Retinal fundus photograph.
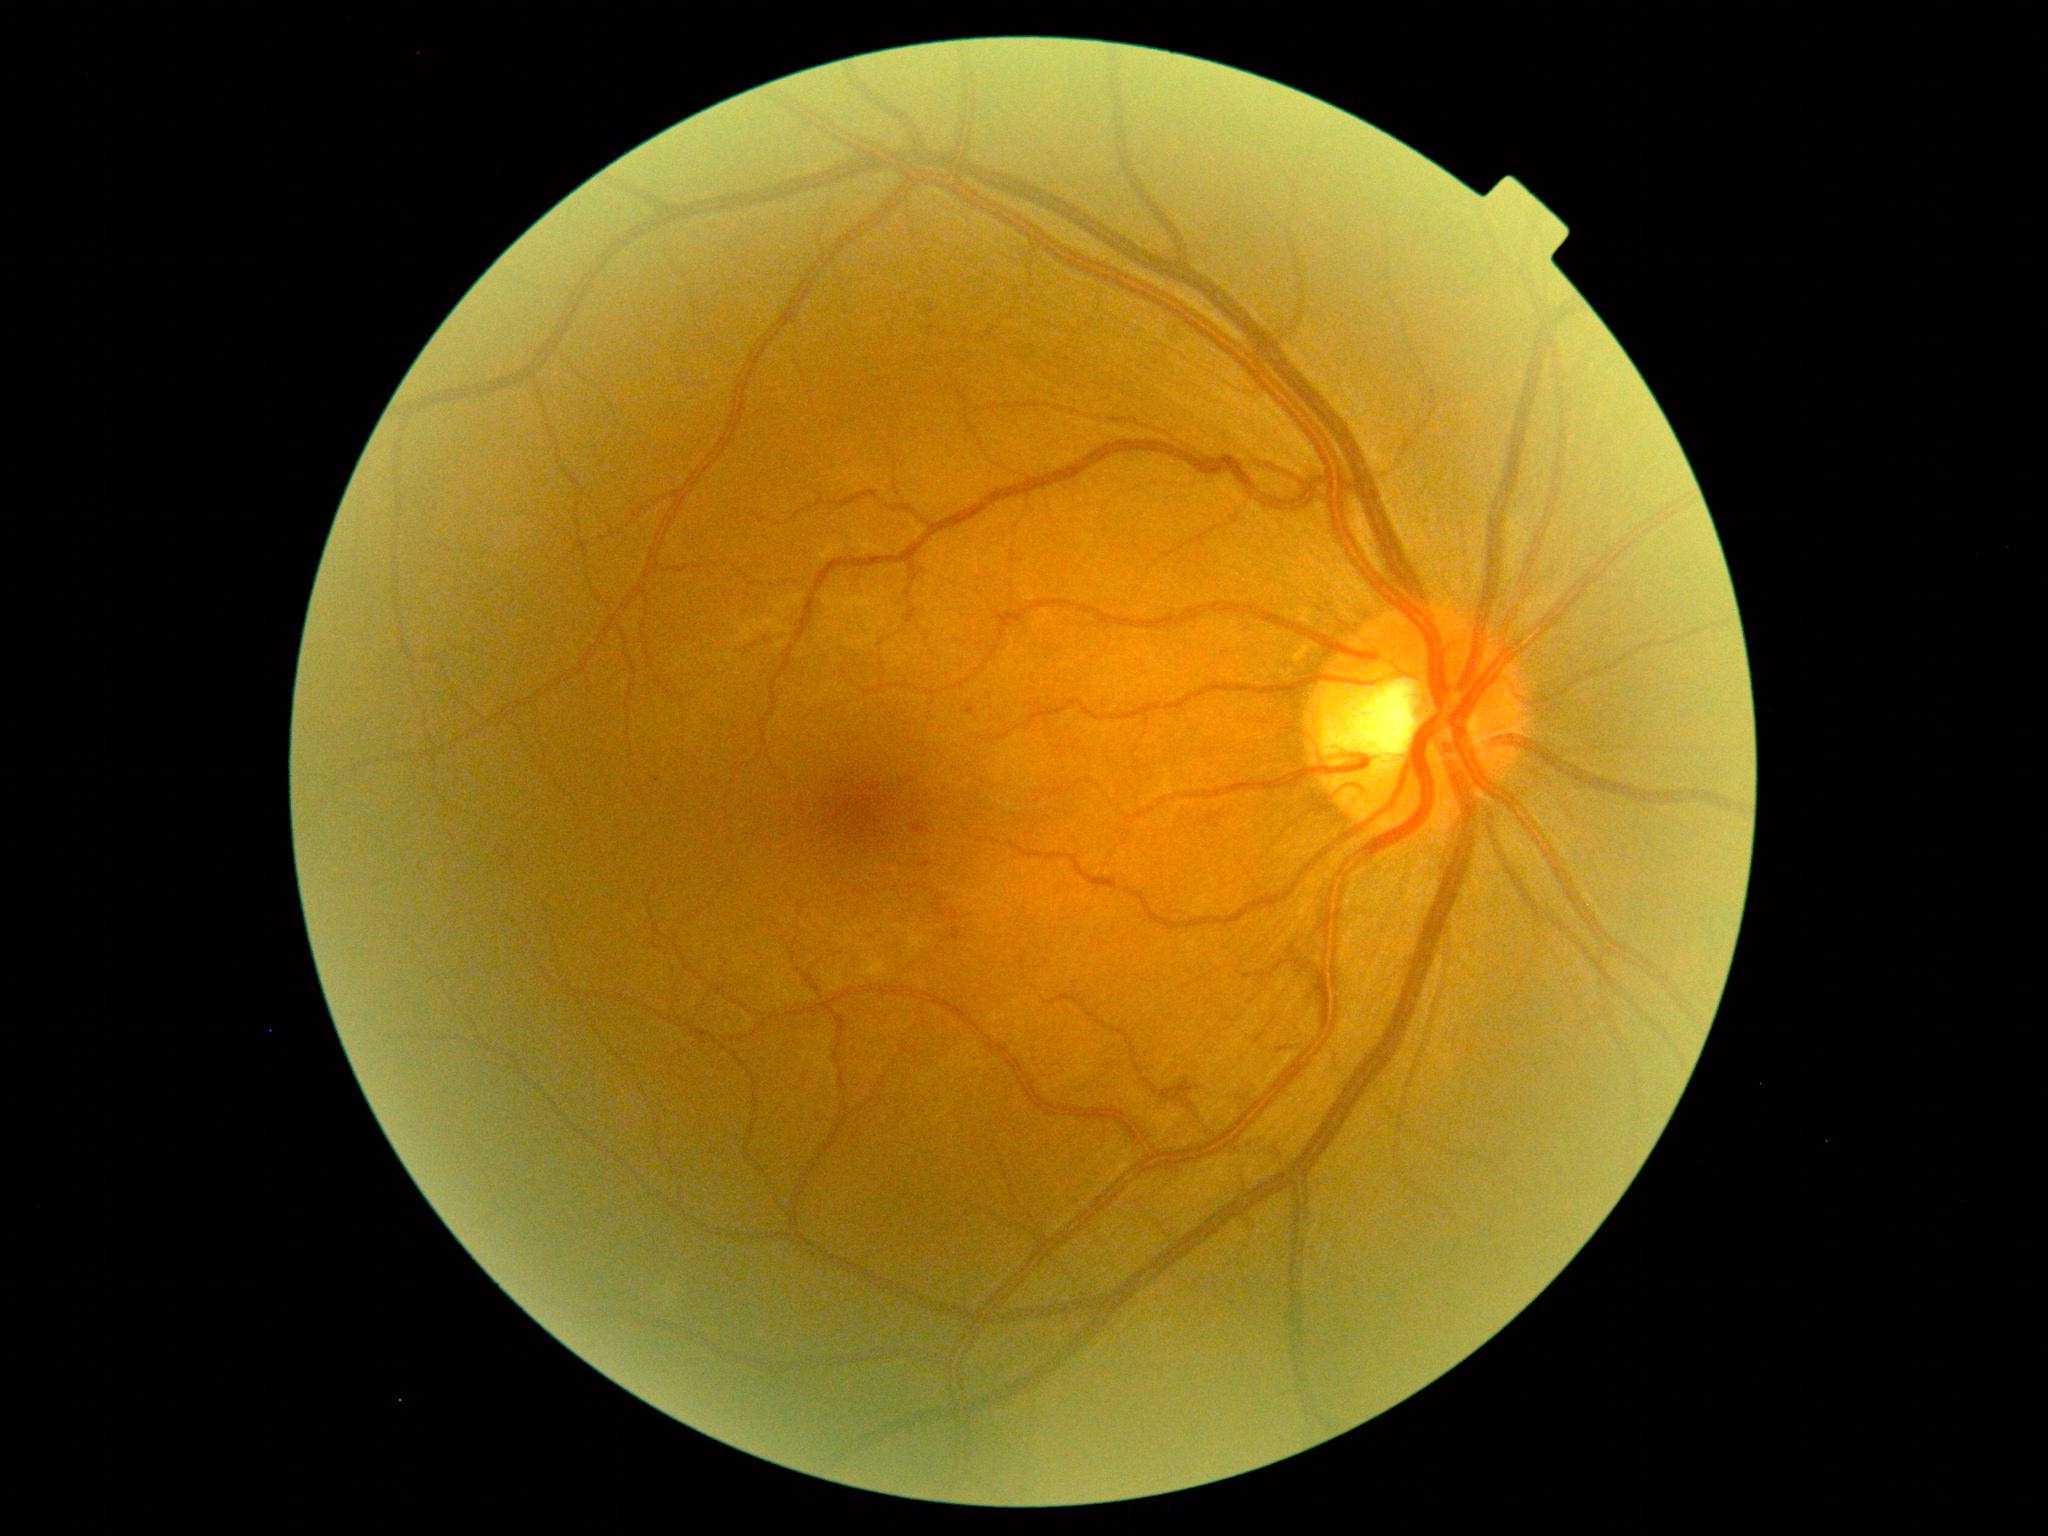

DR: 1/4; DR class: non-proliferative diabetic retinopathy.